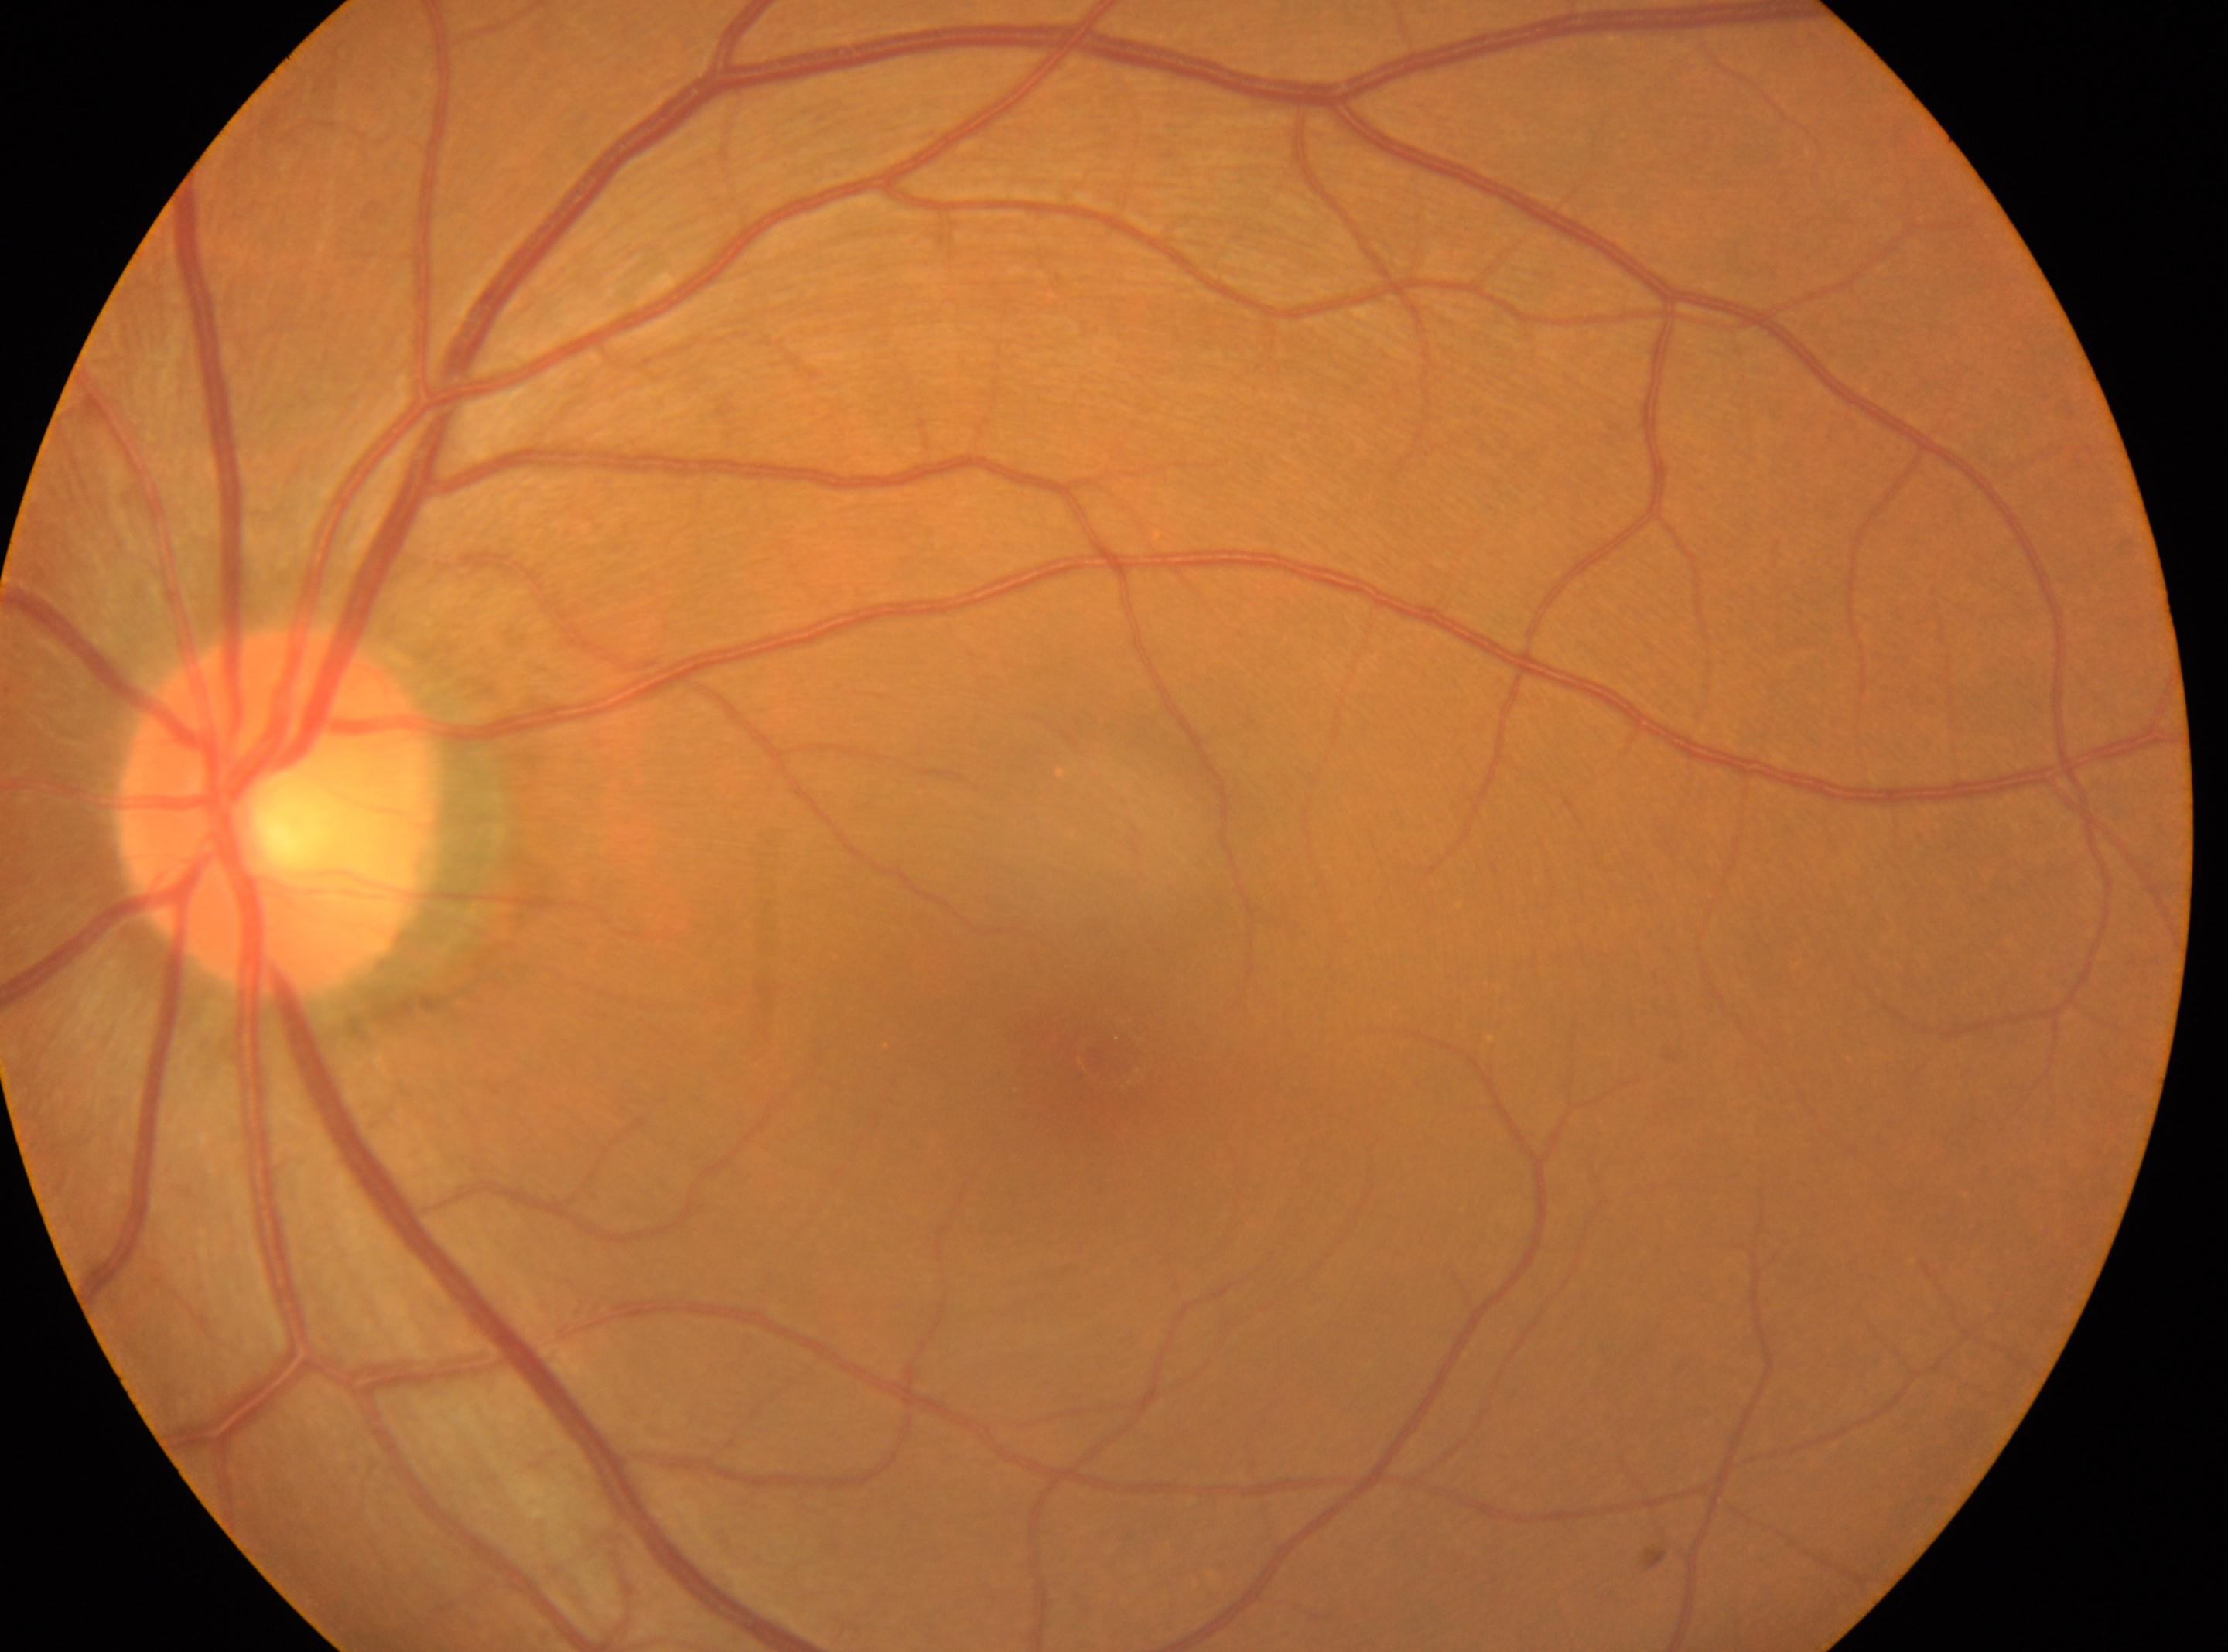 No signs of diabetic retinopathy | oculus sinister | optic disk@(x: 280, y: 811) | retinopathy@0/4 | fovea centralis@(x: 1108, y: 1055).